Color fundus photograph
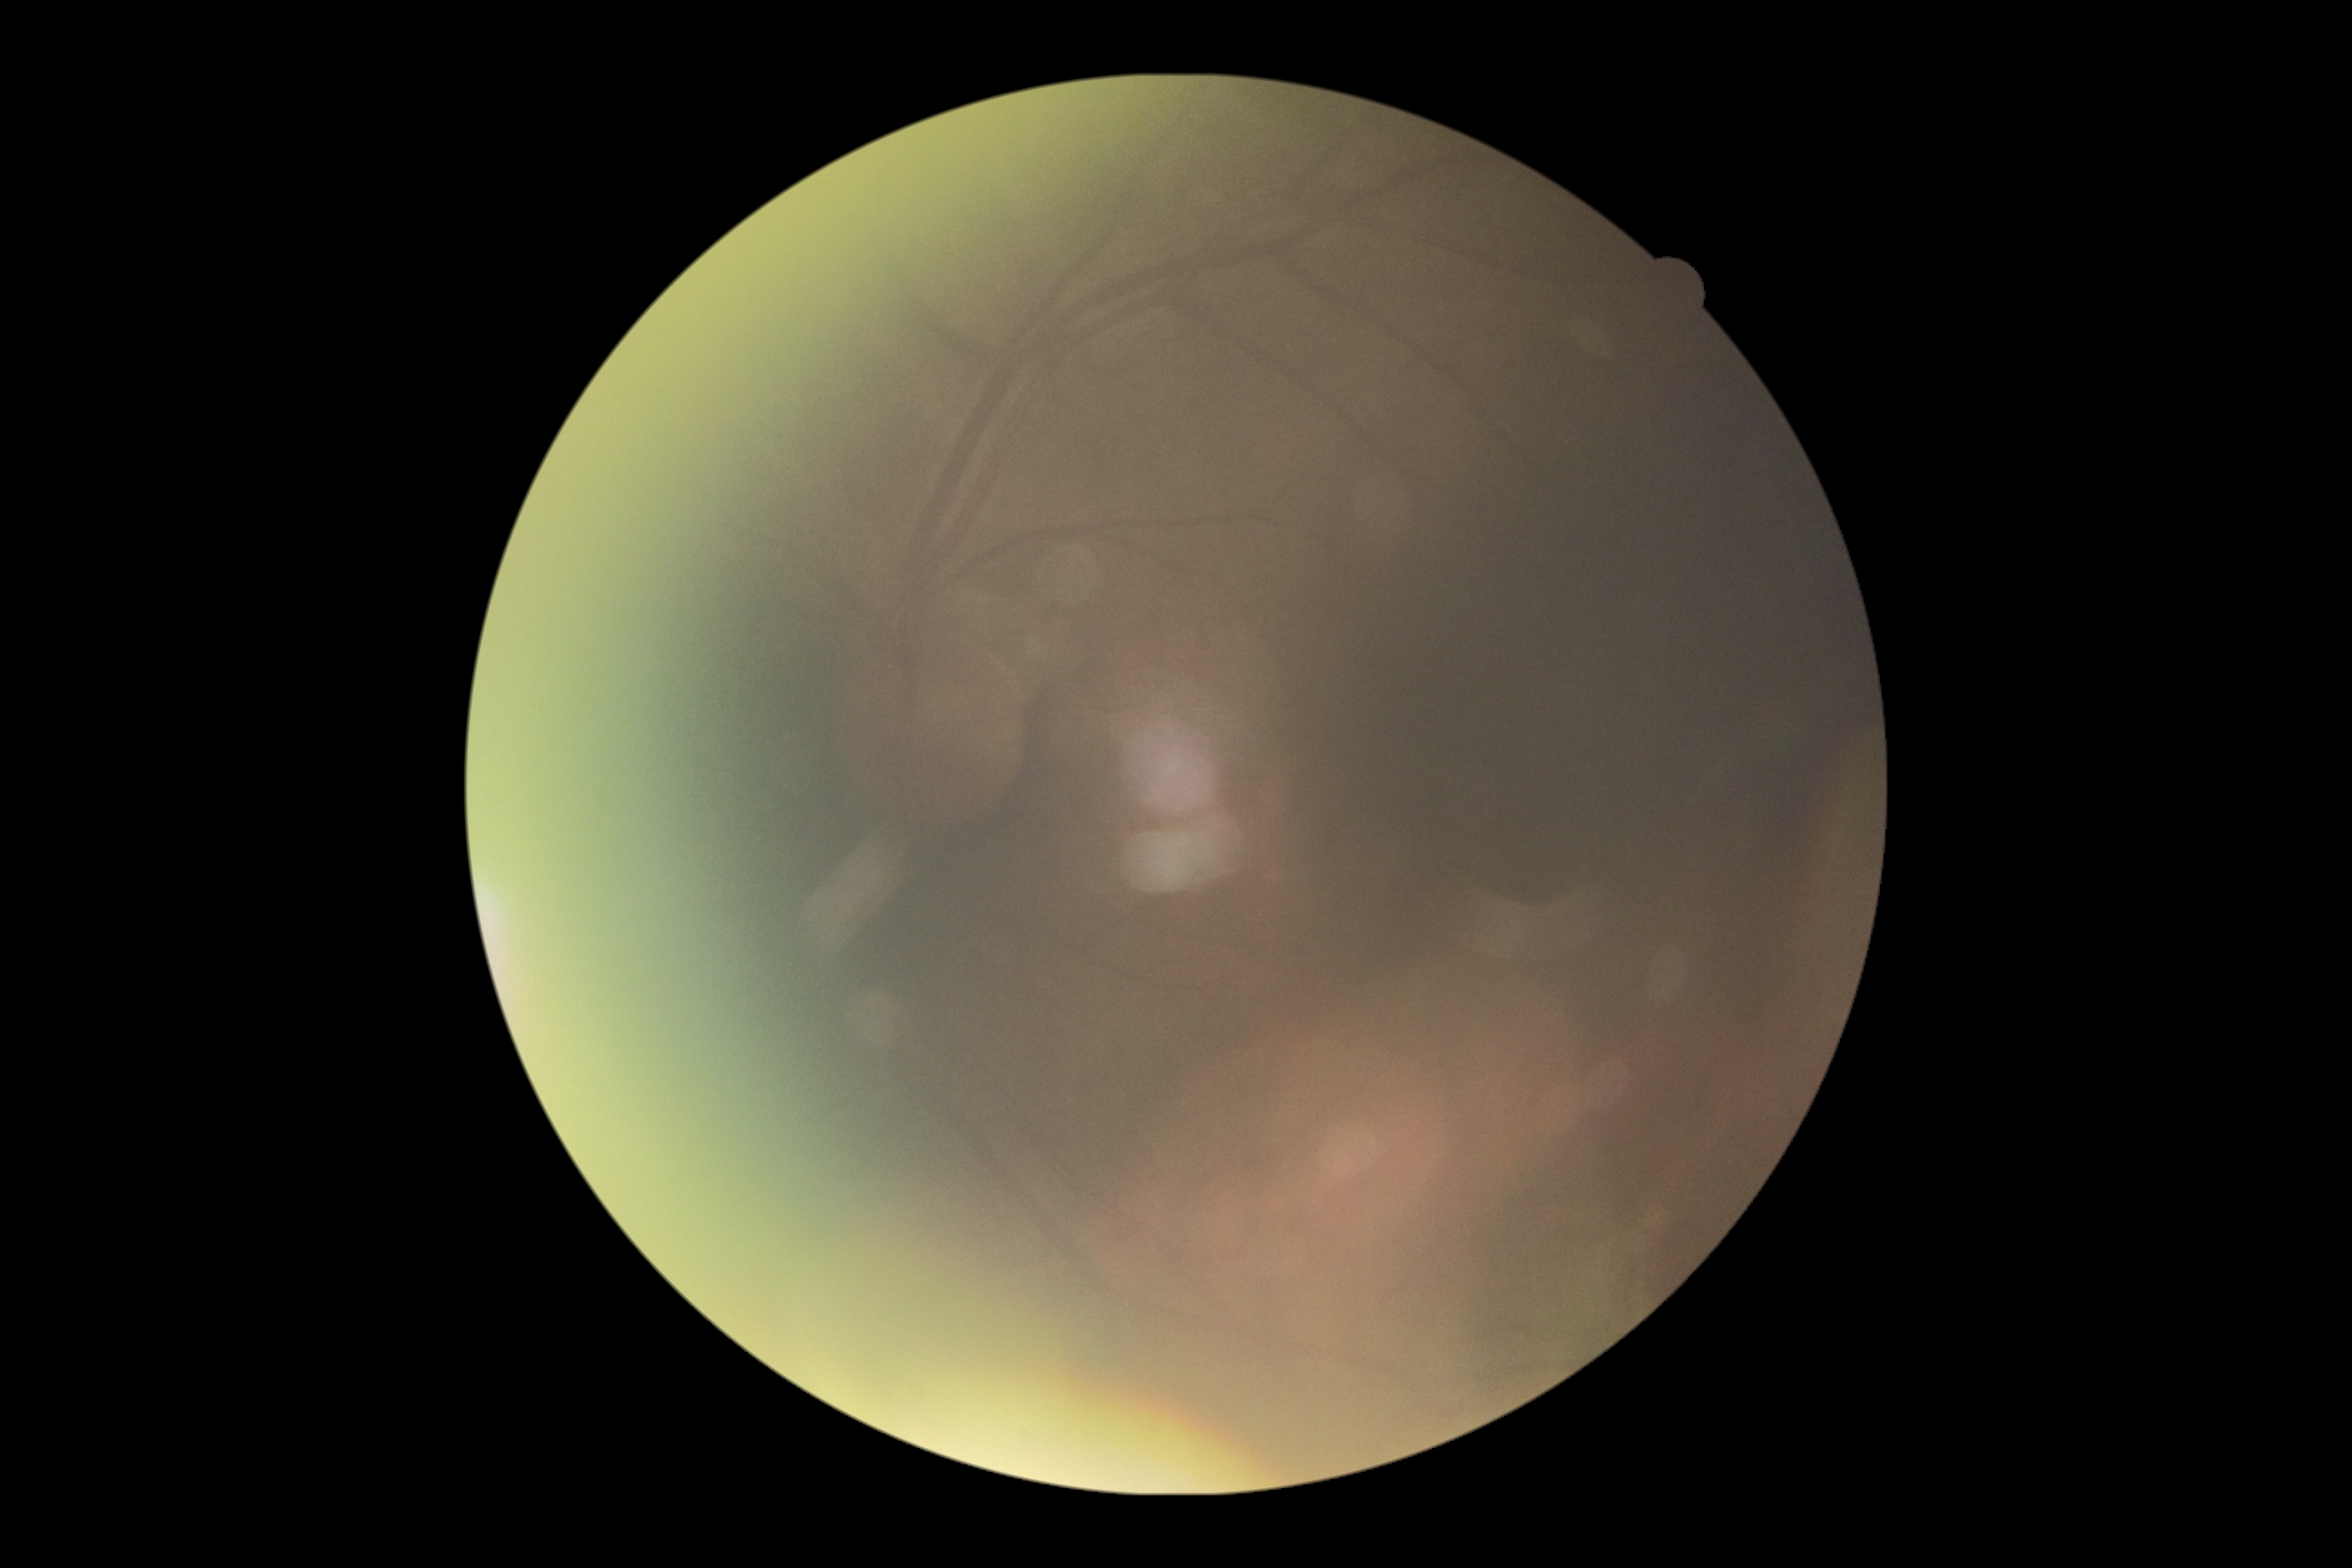

Quality too poor to assess for DR. Diabetic retinopathy (DR): ungradable.